45° field of view · posterior pole color fundus photograph.
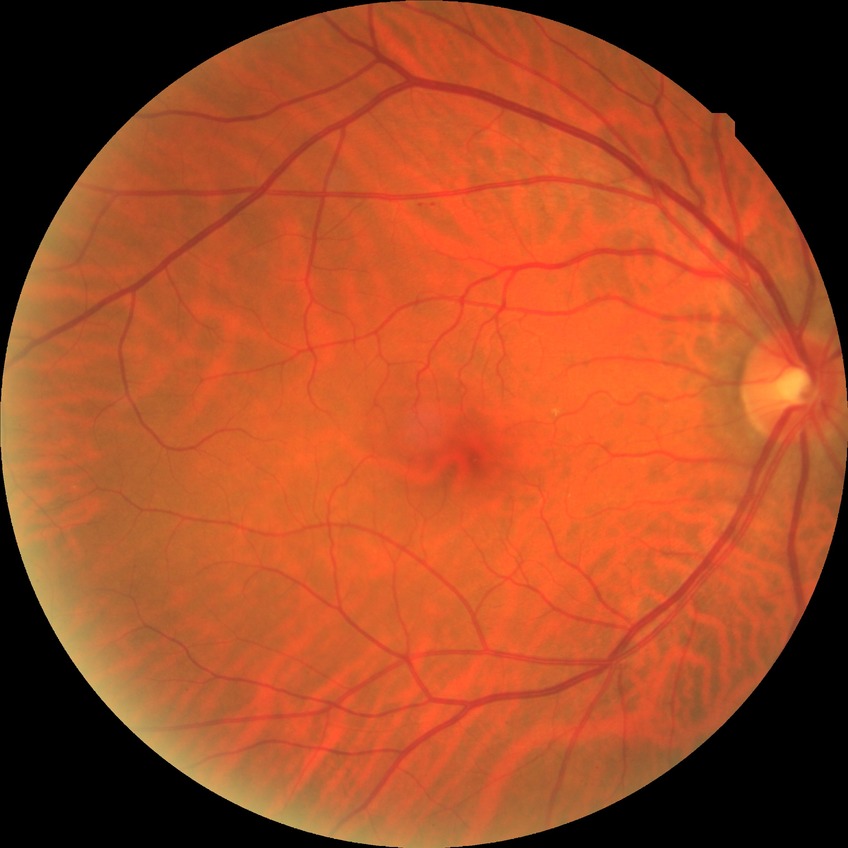

{
  "davis_grade": "NDR (no diabetic retinopathy)"
}